45-degree field of view; retinal fundus photograph.
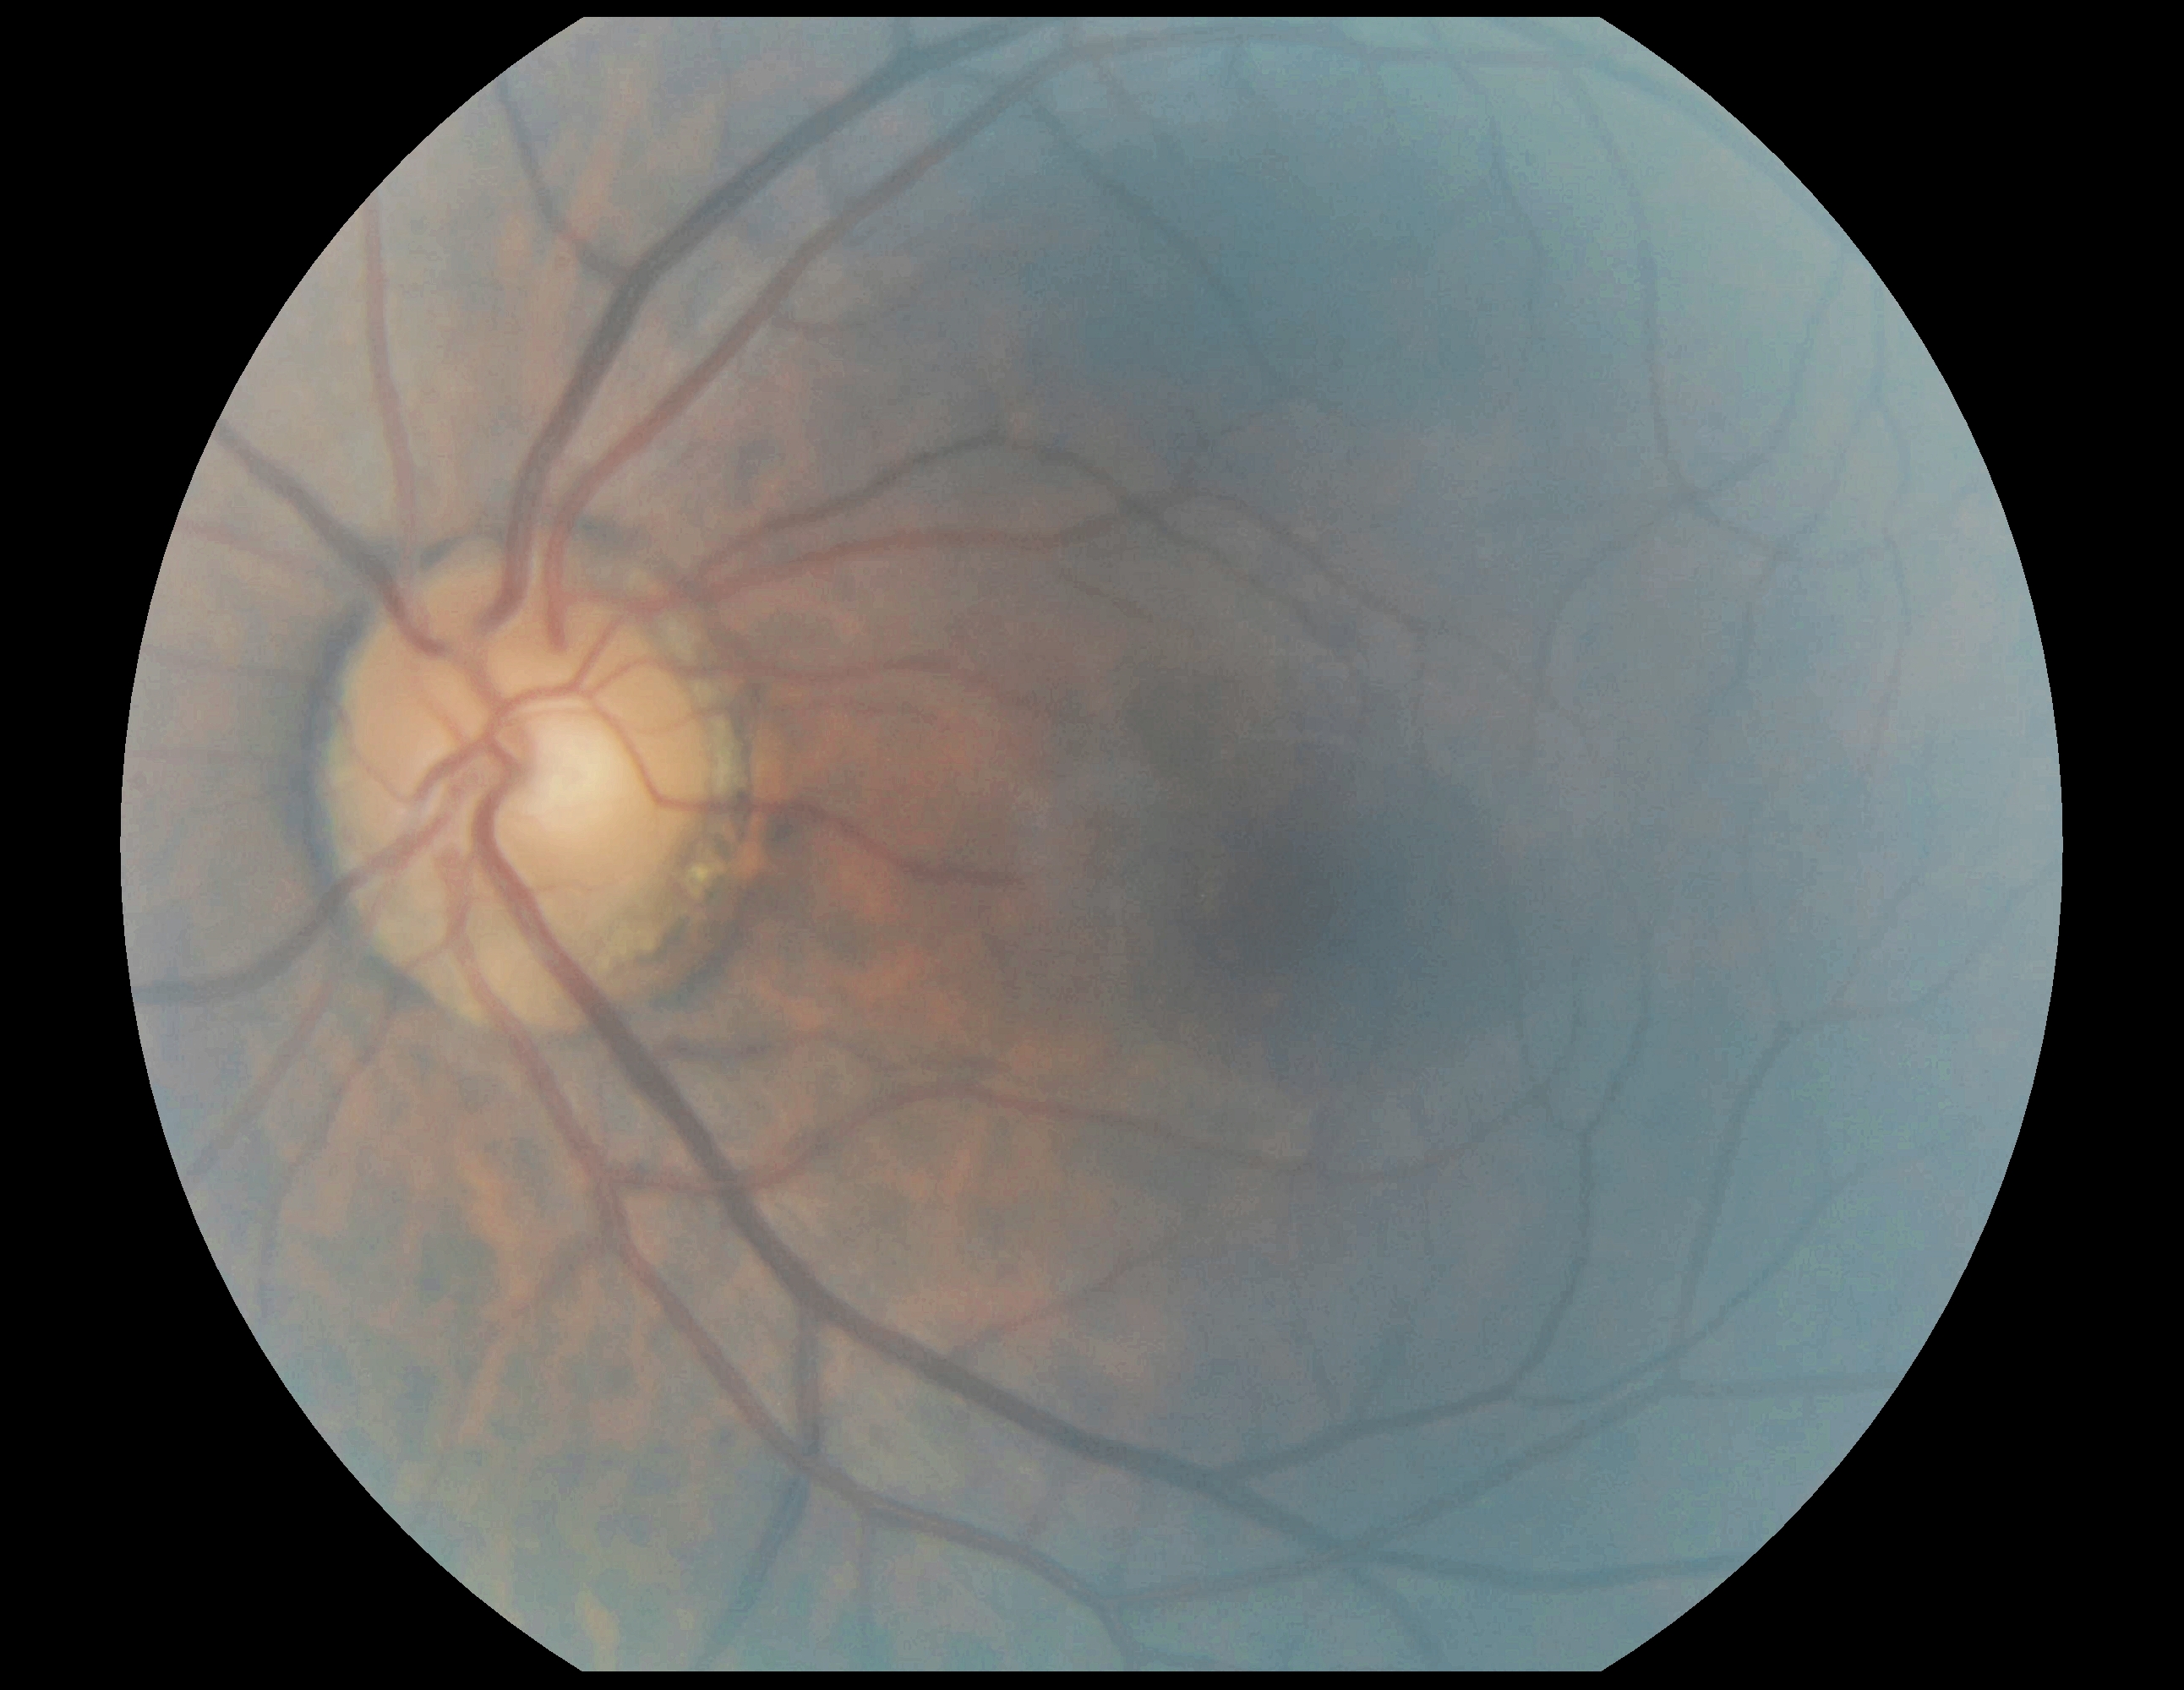
DR stage is grade 0 (no apparent retinopathy).